Nonmydriatic fundus photograph; 45° FOV; Davis DR grading:
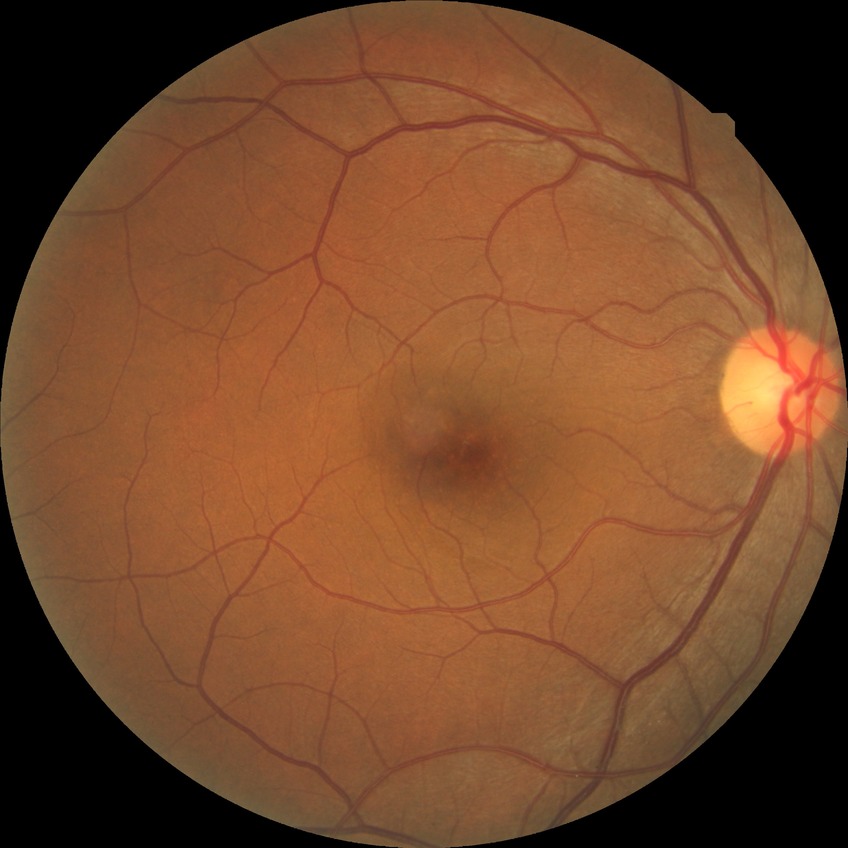

Diabetic retinopathy (DR) is NDR (no diabetic retinopathy).